Modified Davis classification, without pupil dilation, NIDEK AFC-230, 45-degree field of view — 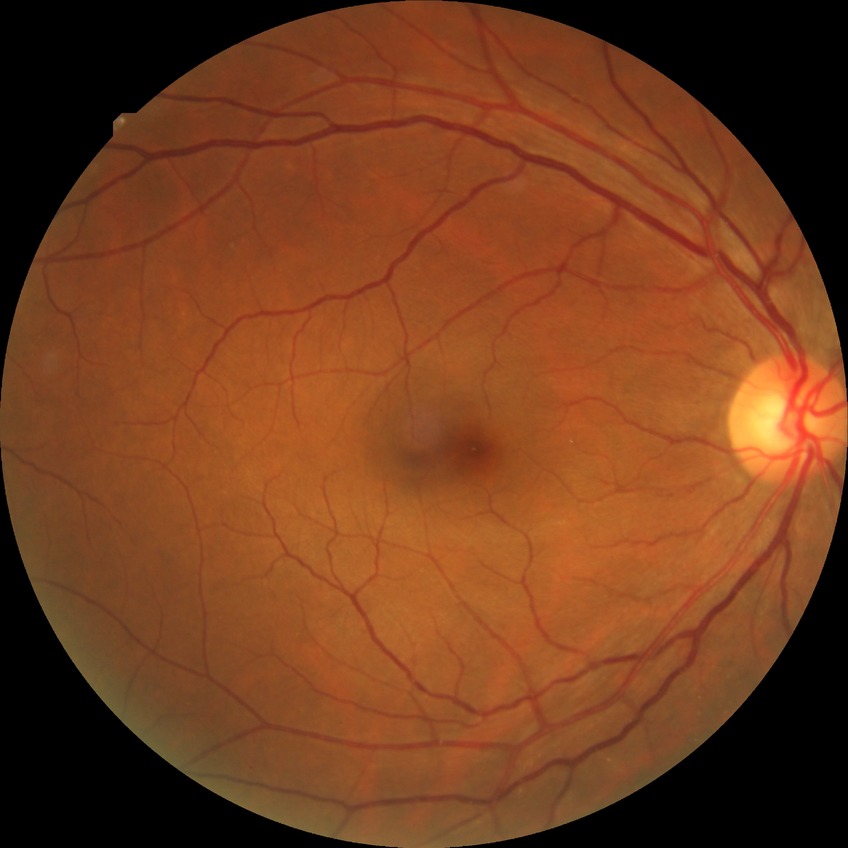
Diabetic retinopathy stage: no diabetic retinopathy.